CFP.
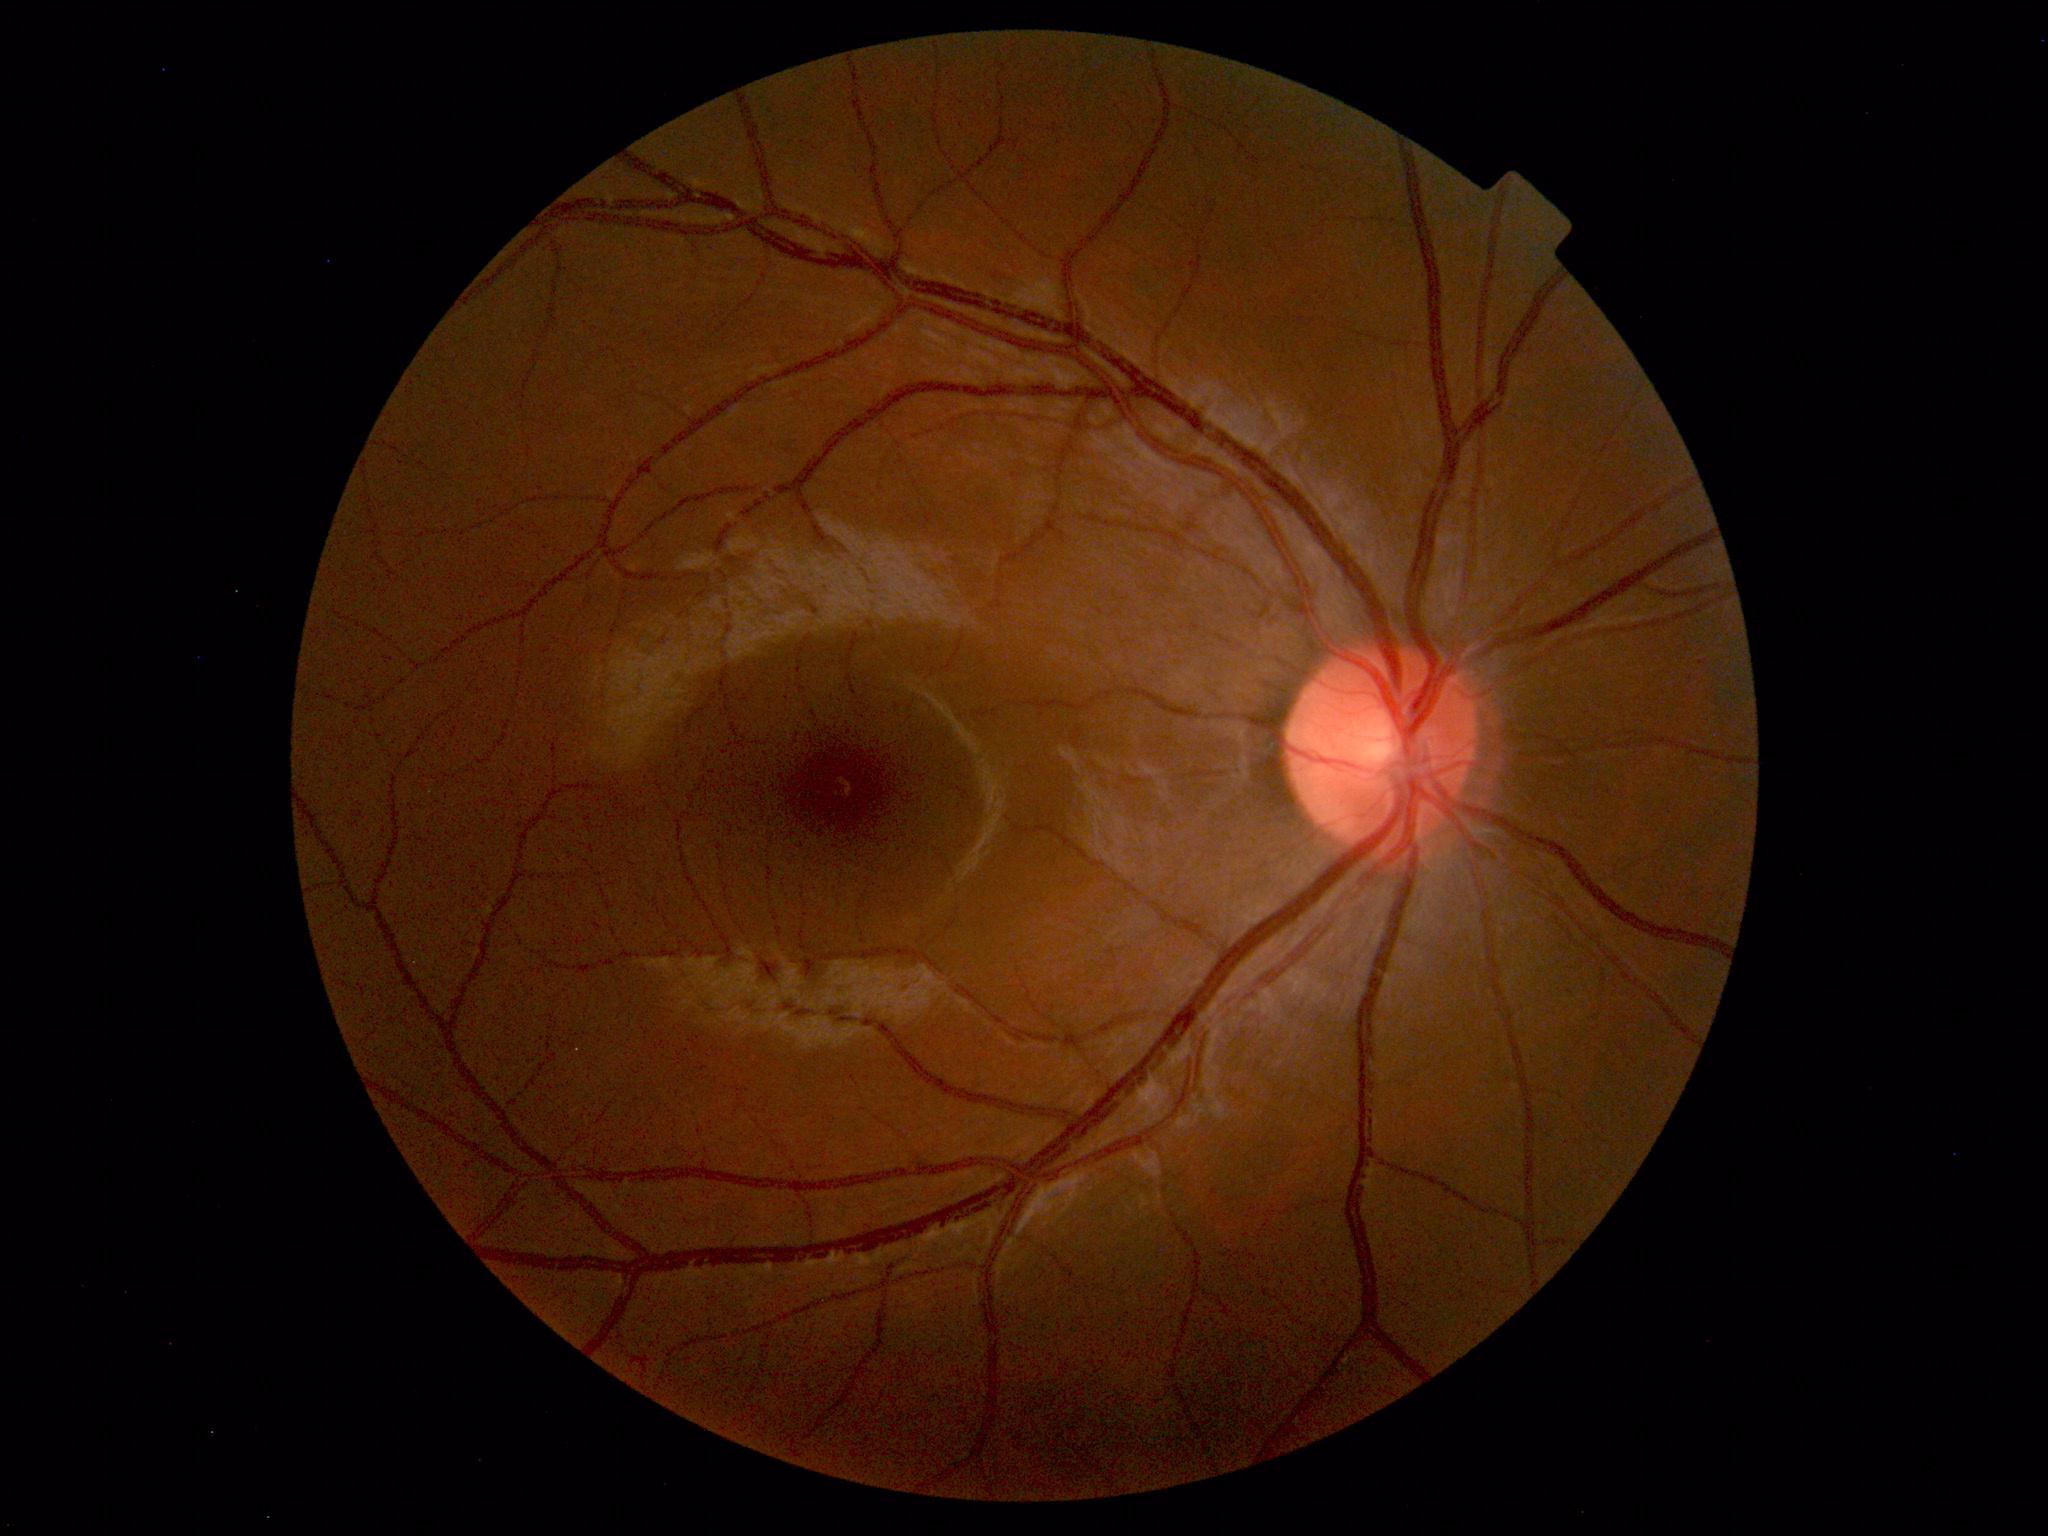
Within normal limits. No abnormalities identified.